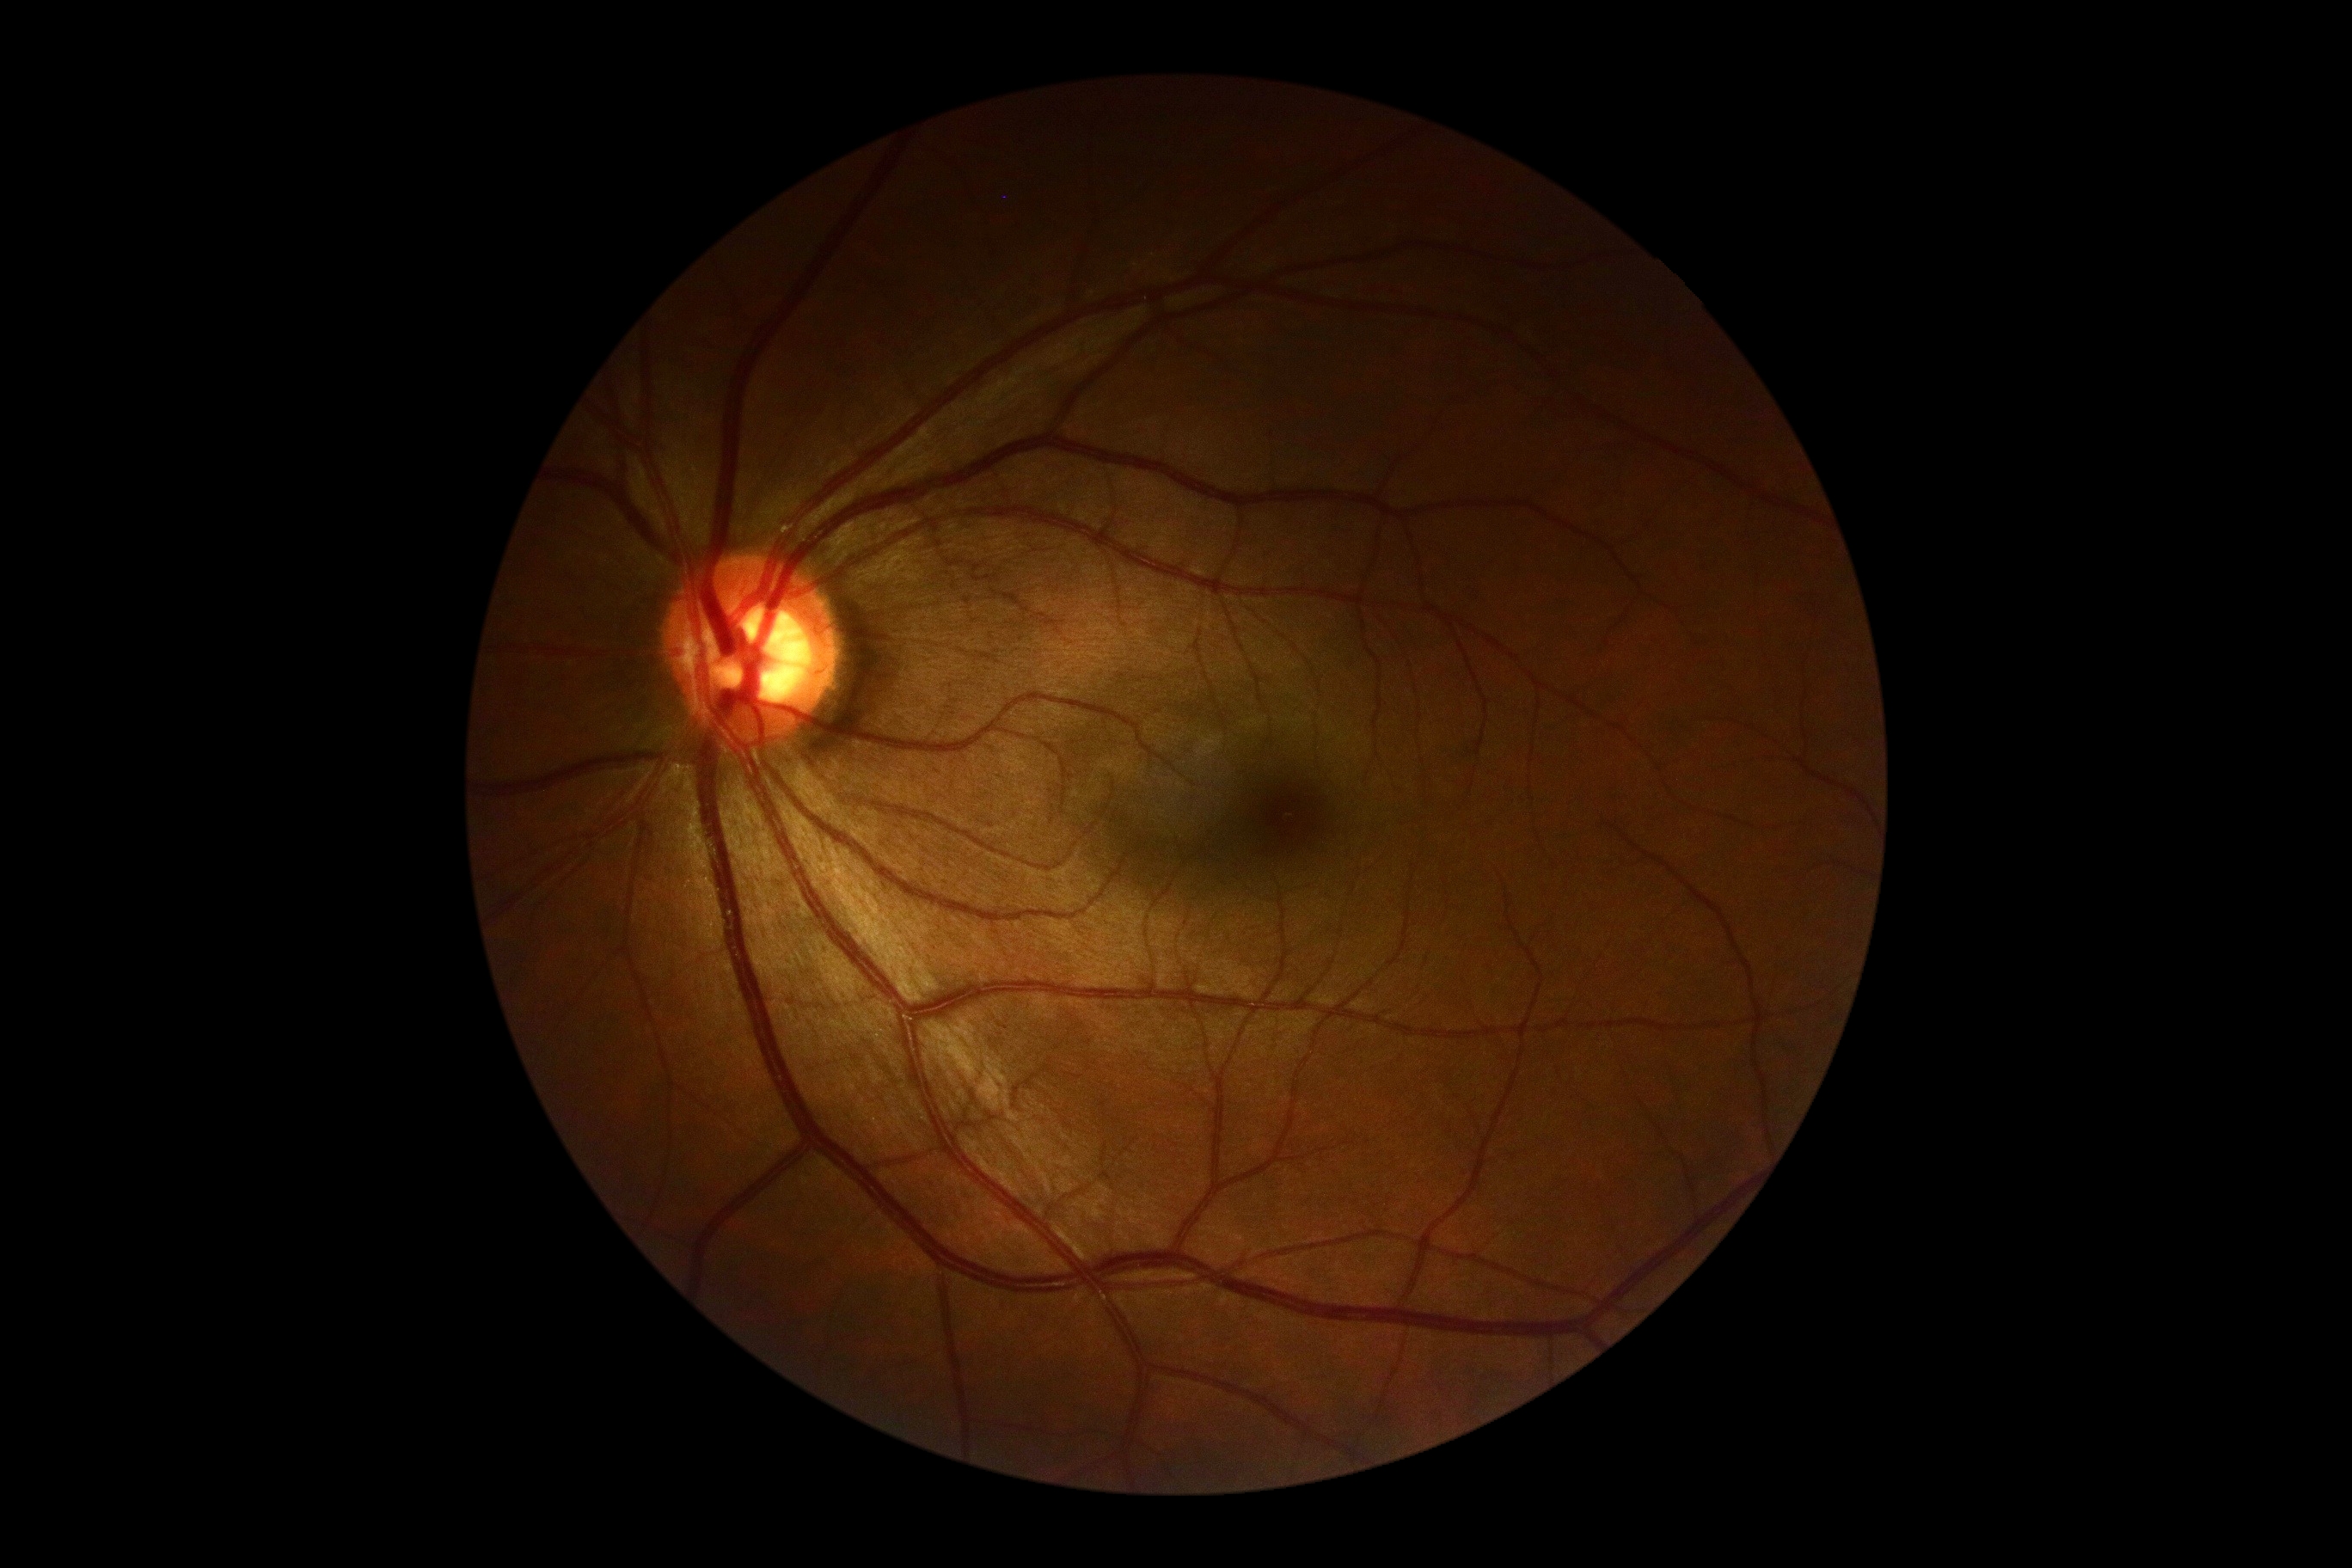

dr_grade: no apparent retinopathy (grade 0) — no visible signs of diabetic retinopathy